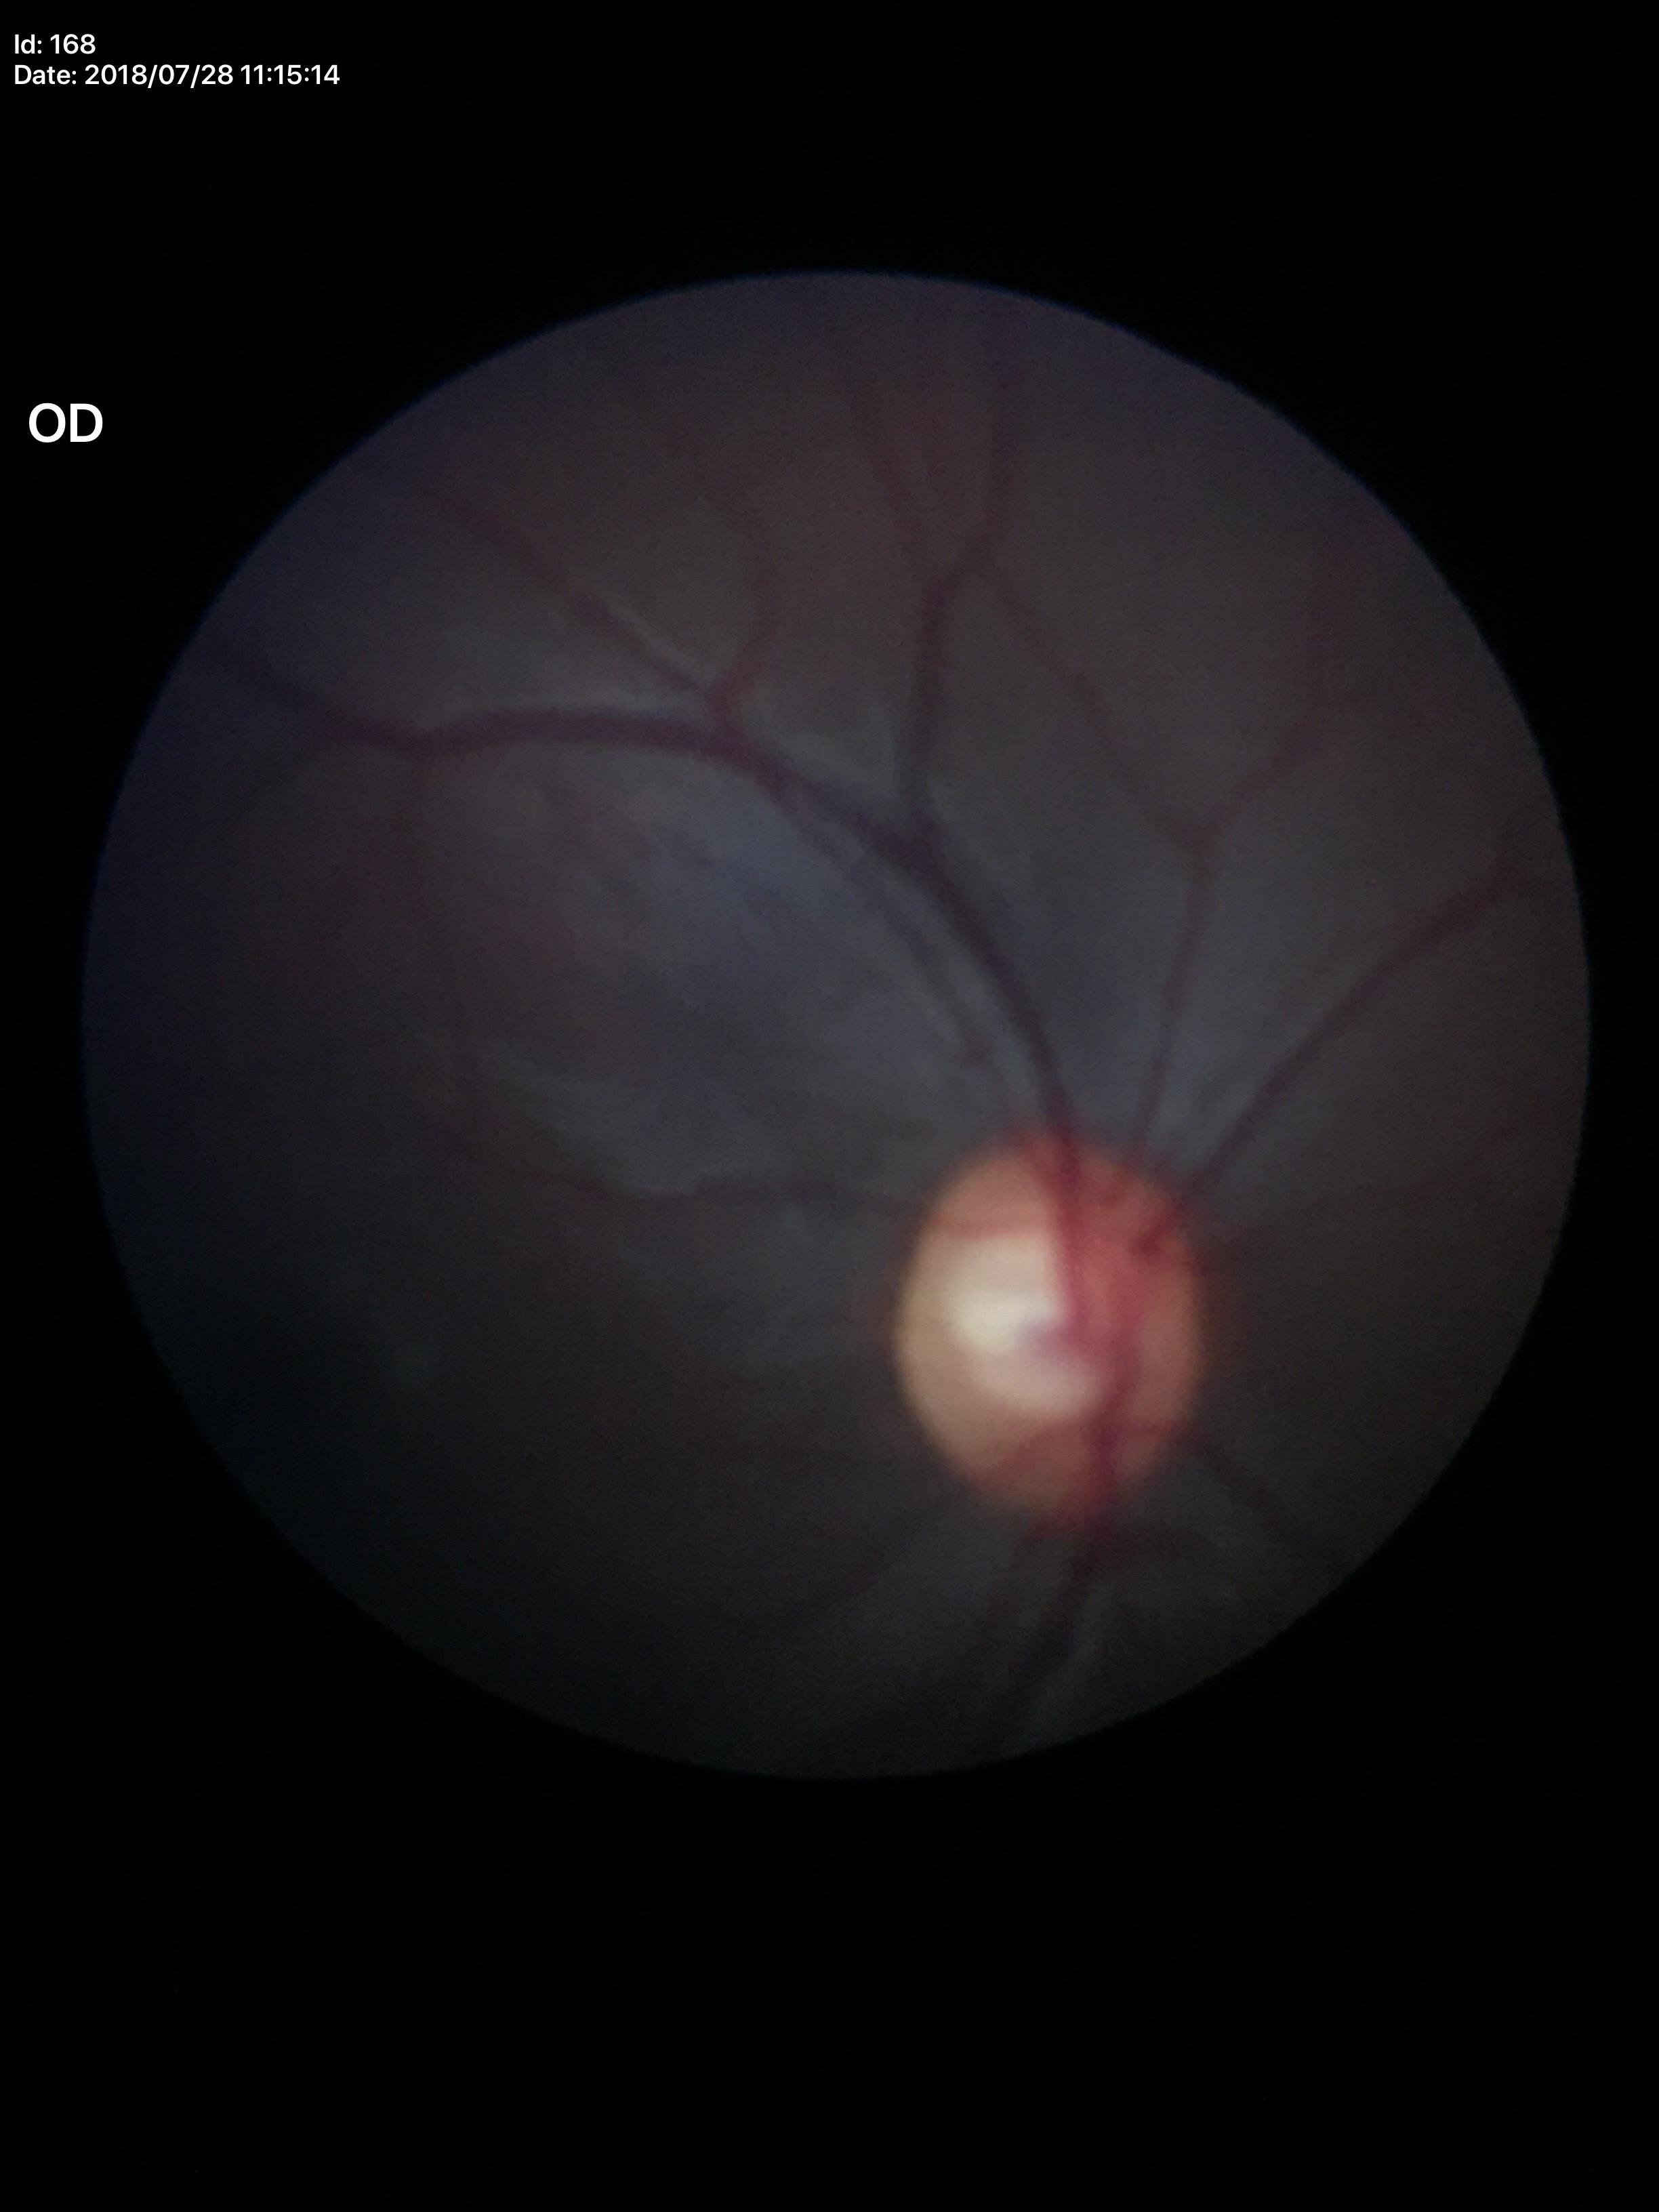
Glaucoma decision: suspicious. Vertical cup-disc ratio (VCDR) of 0.62. Horizontal C/D ratio (HCDR) is 0.66.